Image size 1924x1556:
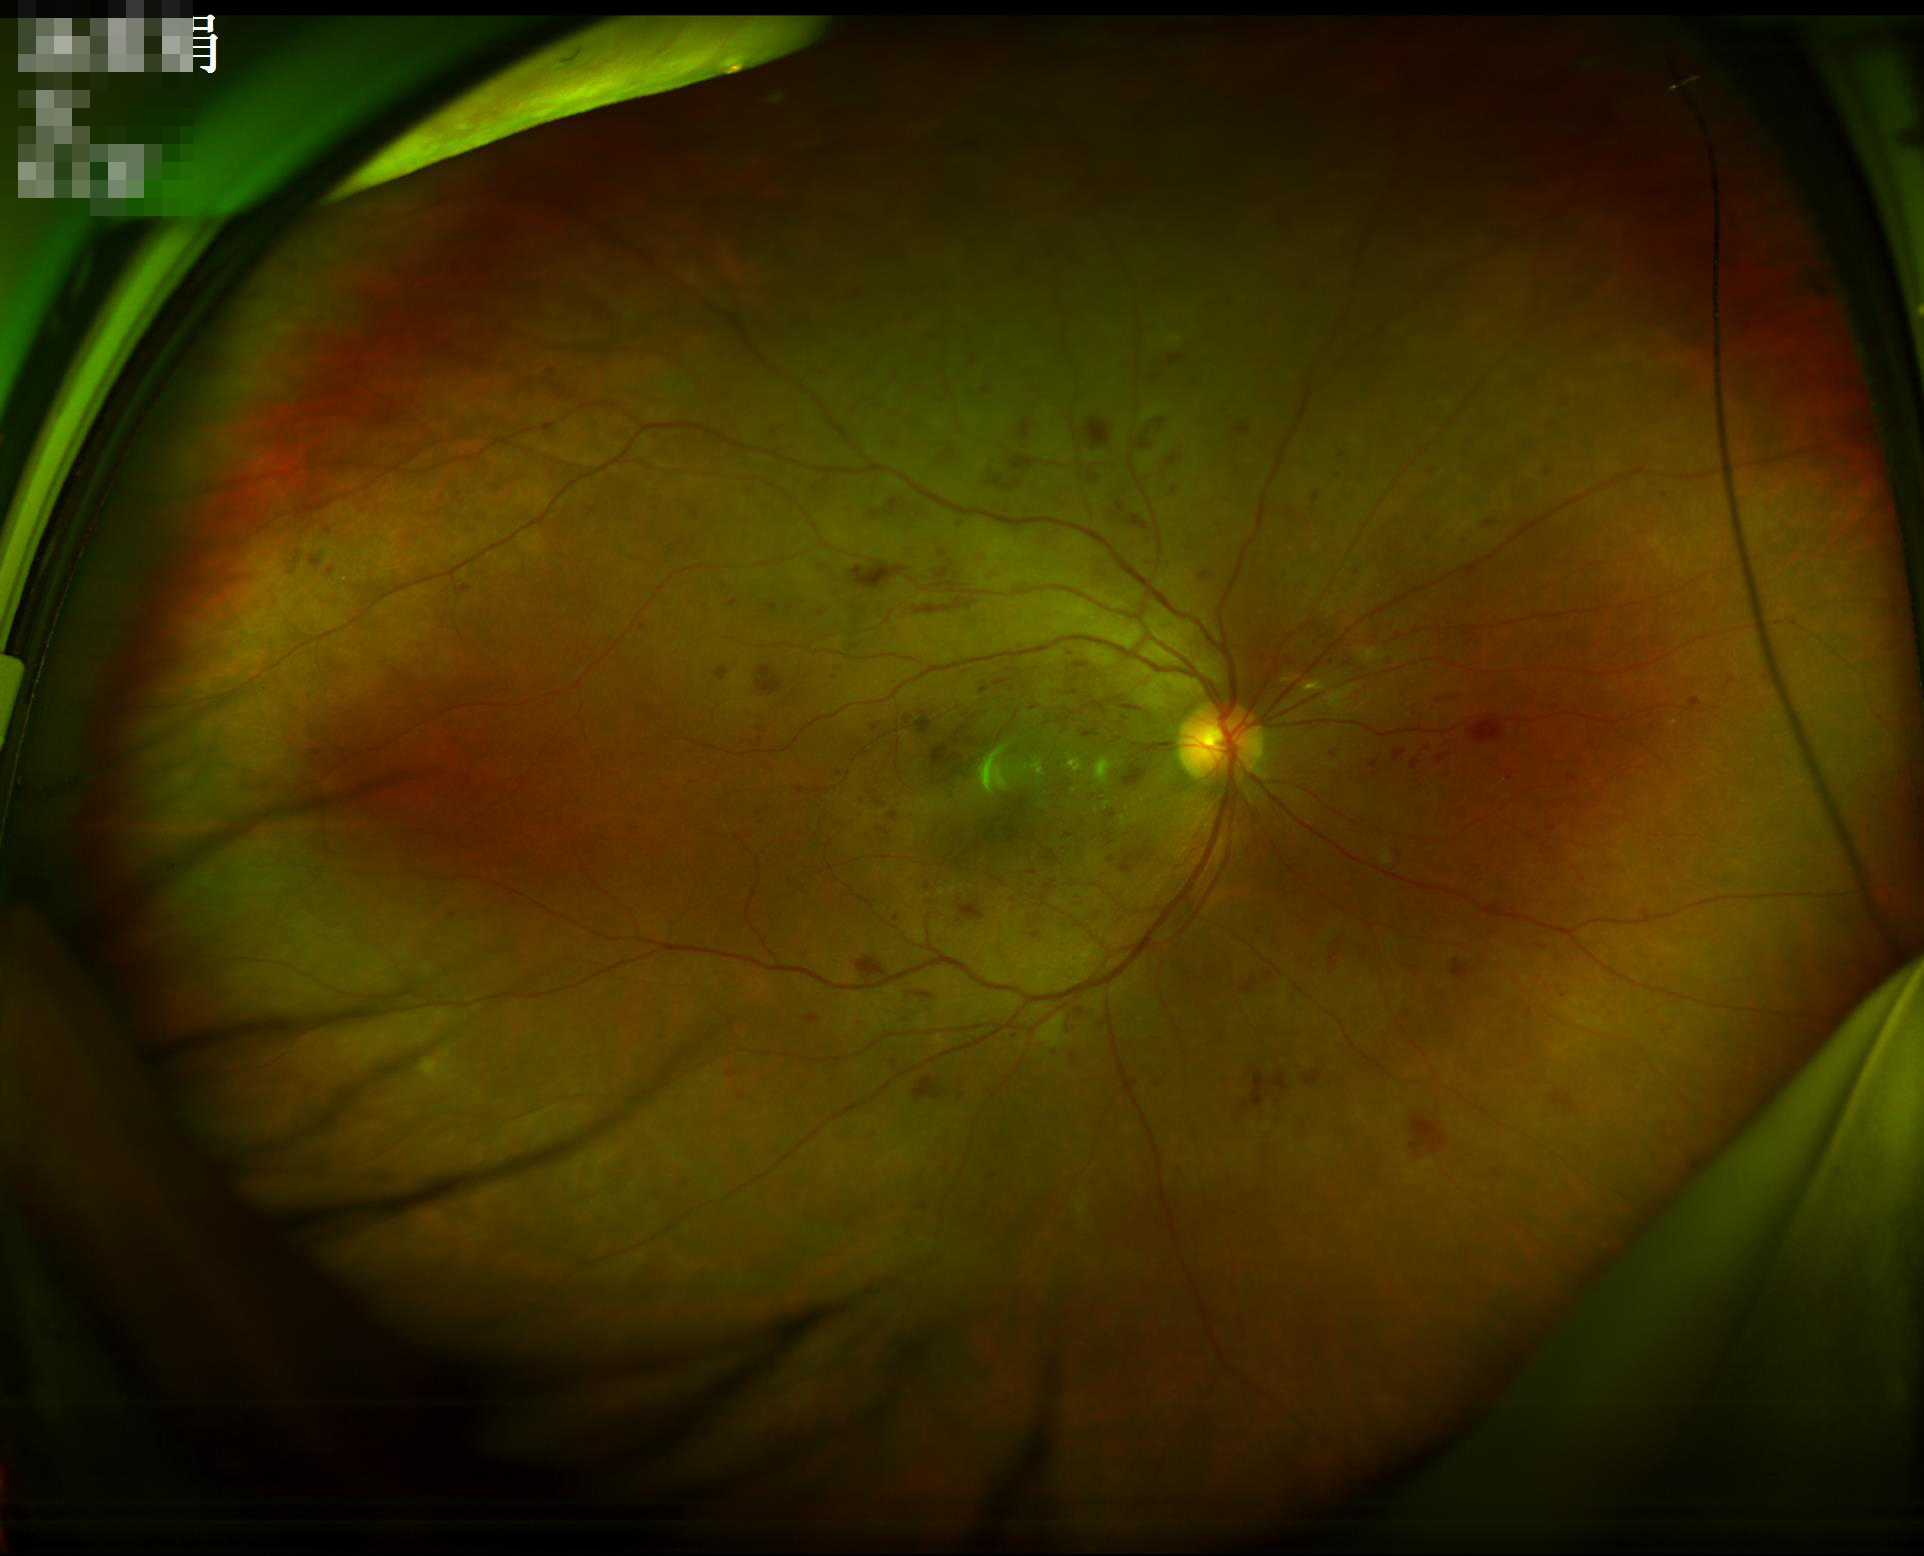
Illumination: even and well-balanced
Overall: good, gradable
Focus: clear with no noticeable blur
Contrast: vessels and details readily distinguishable